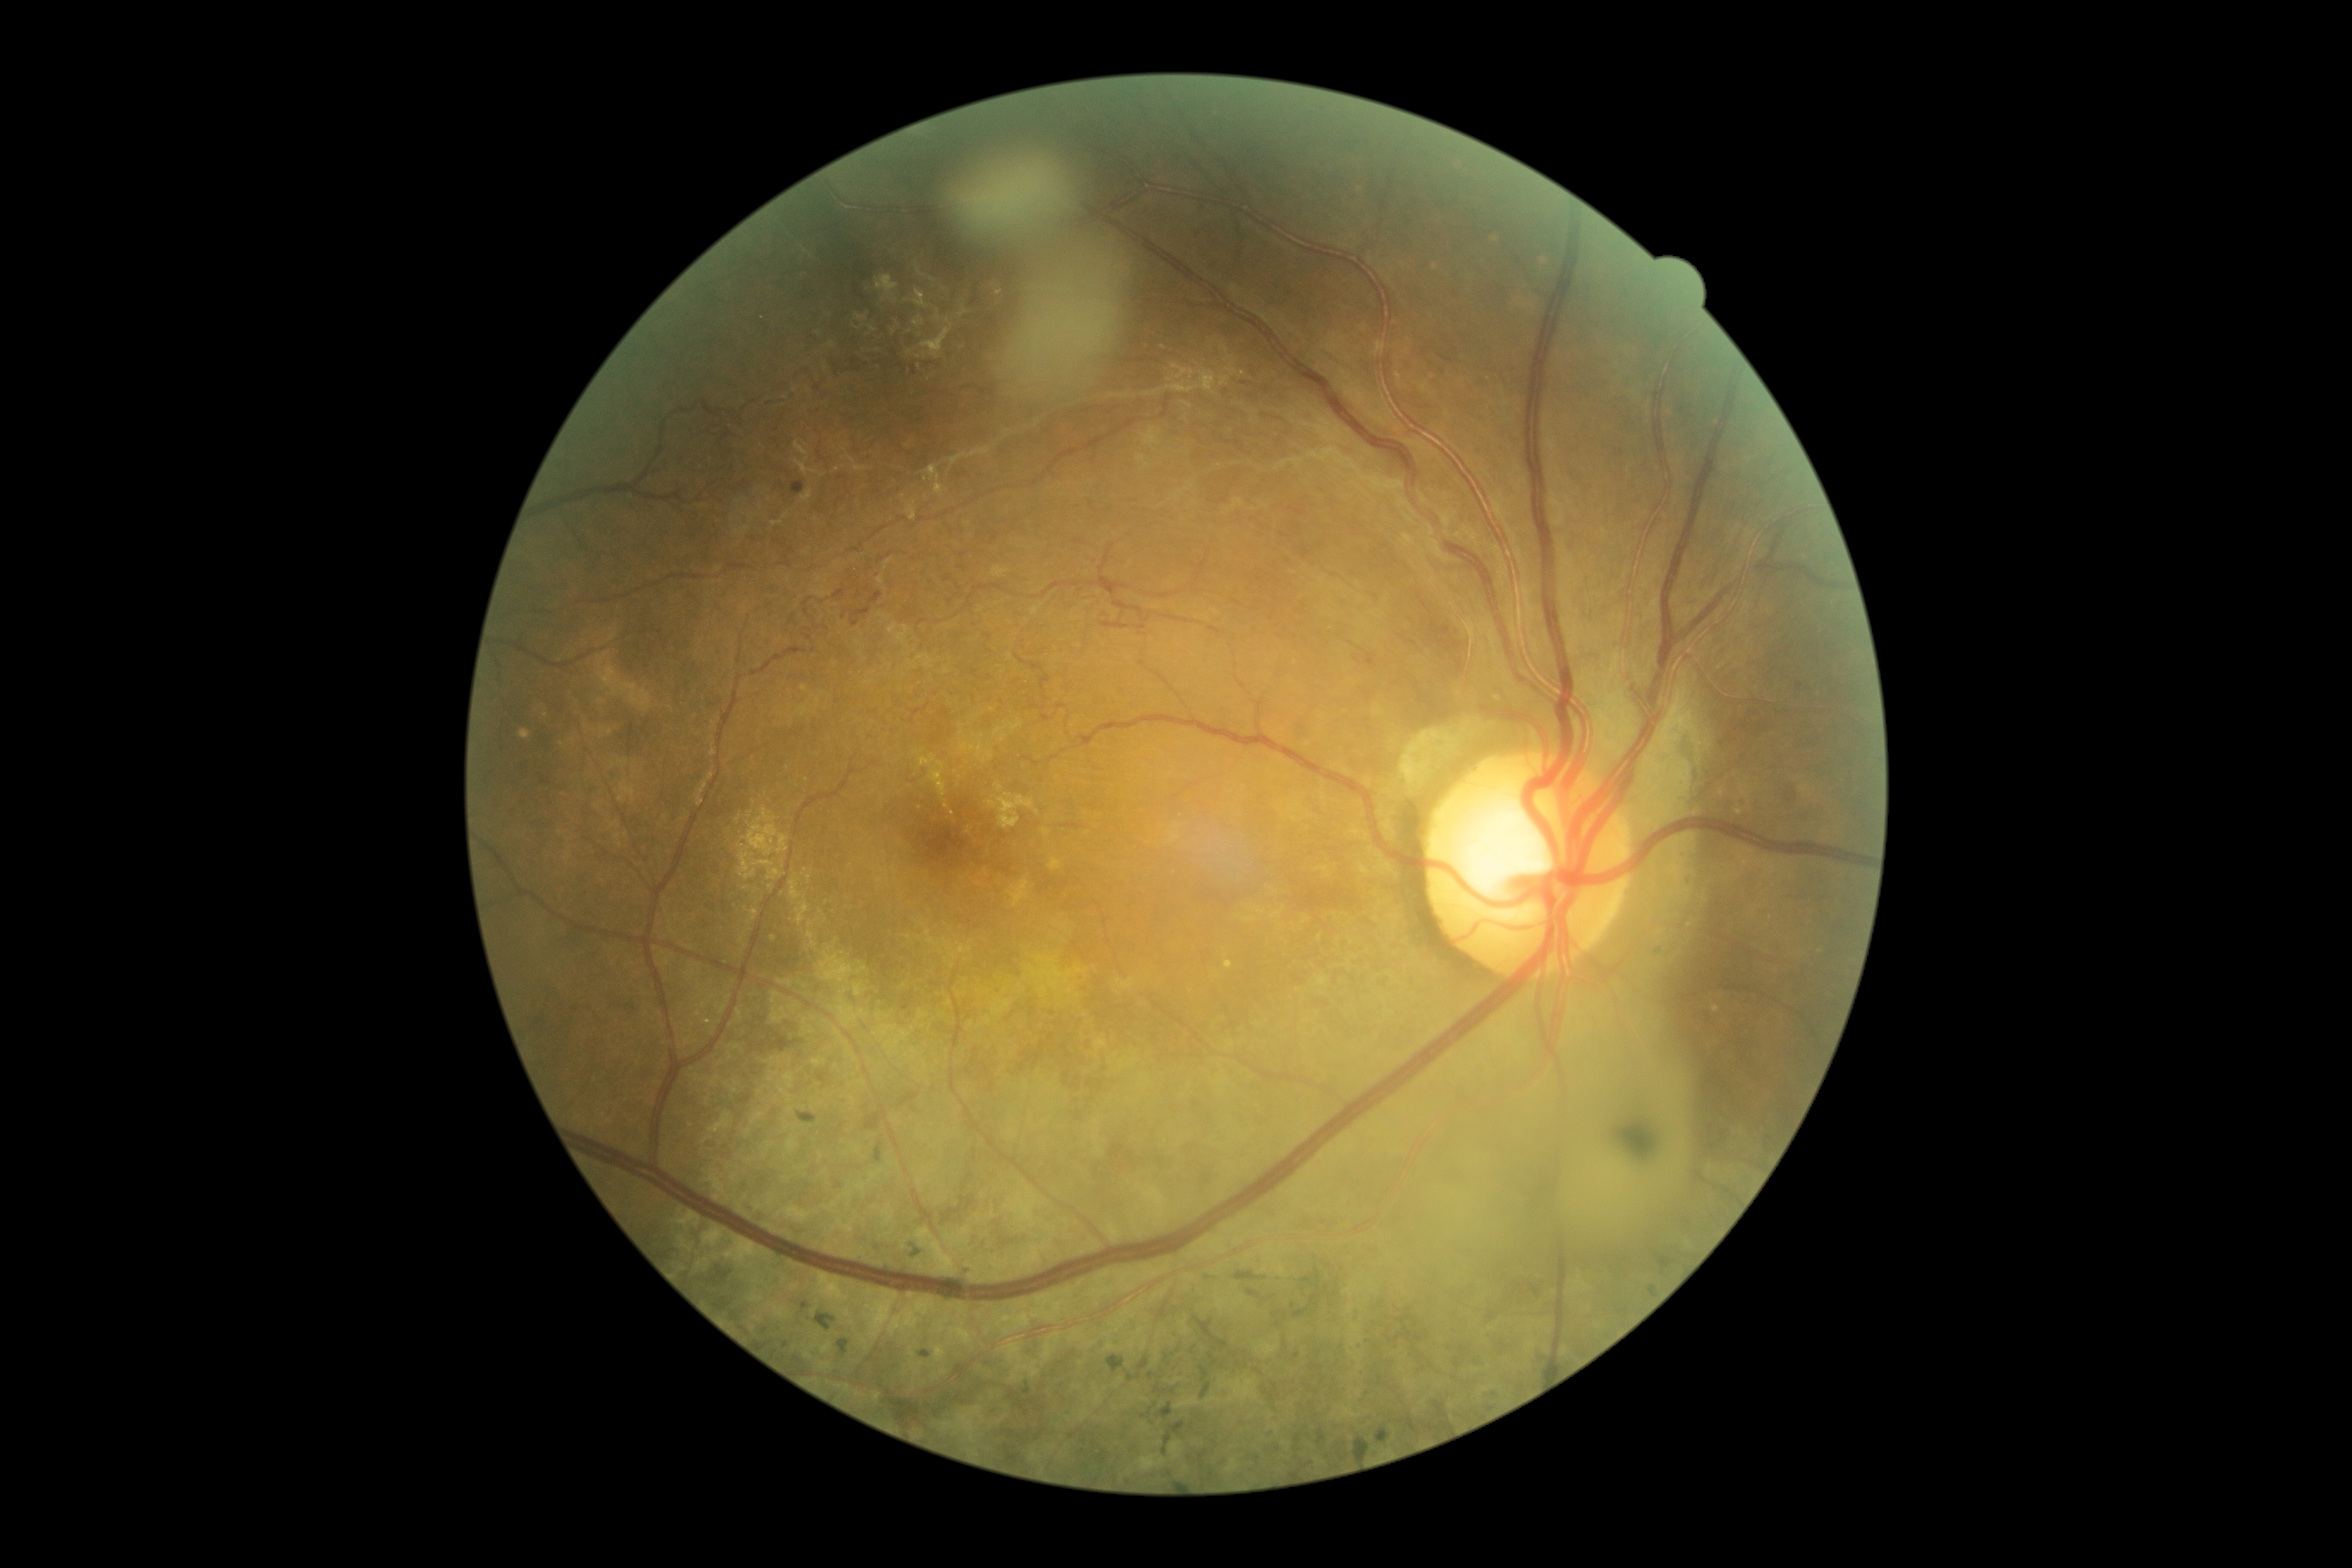
Diabetic retinopathy (DR): 3/4.